240x240: 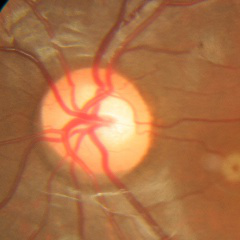

Optic disc photograph demonstrating no glaucoma.